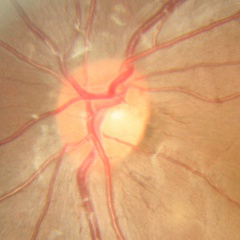

Q: What stage of glaucoma is present?
A: No glaucoma.